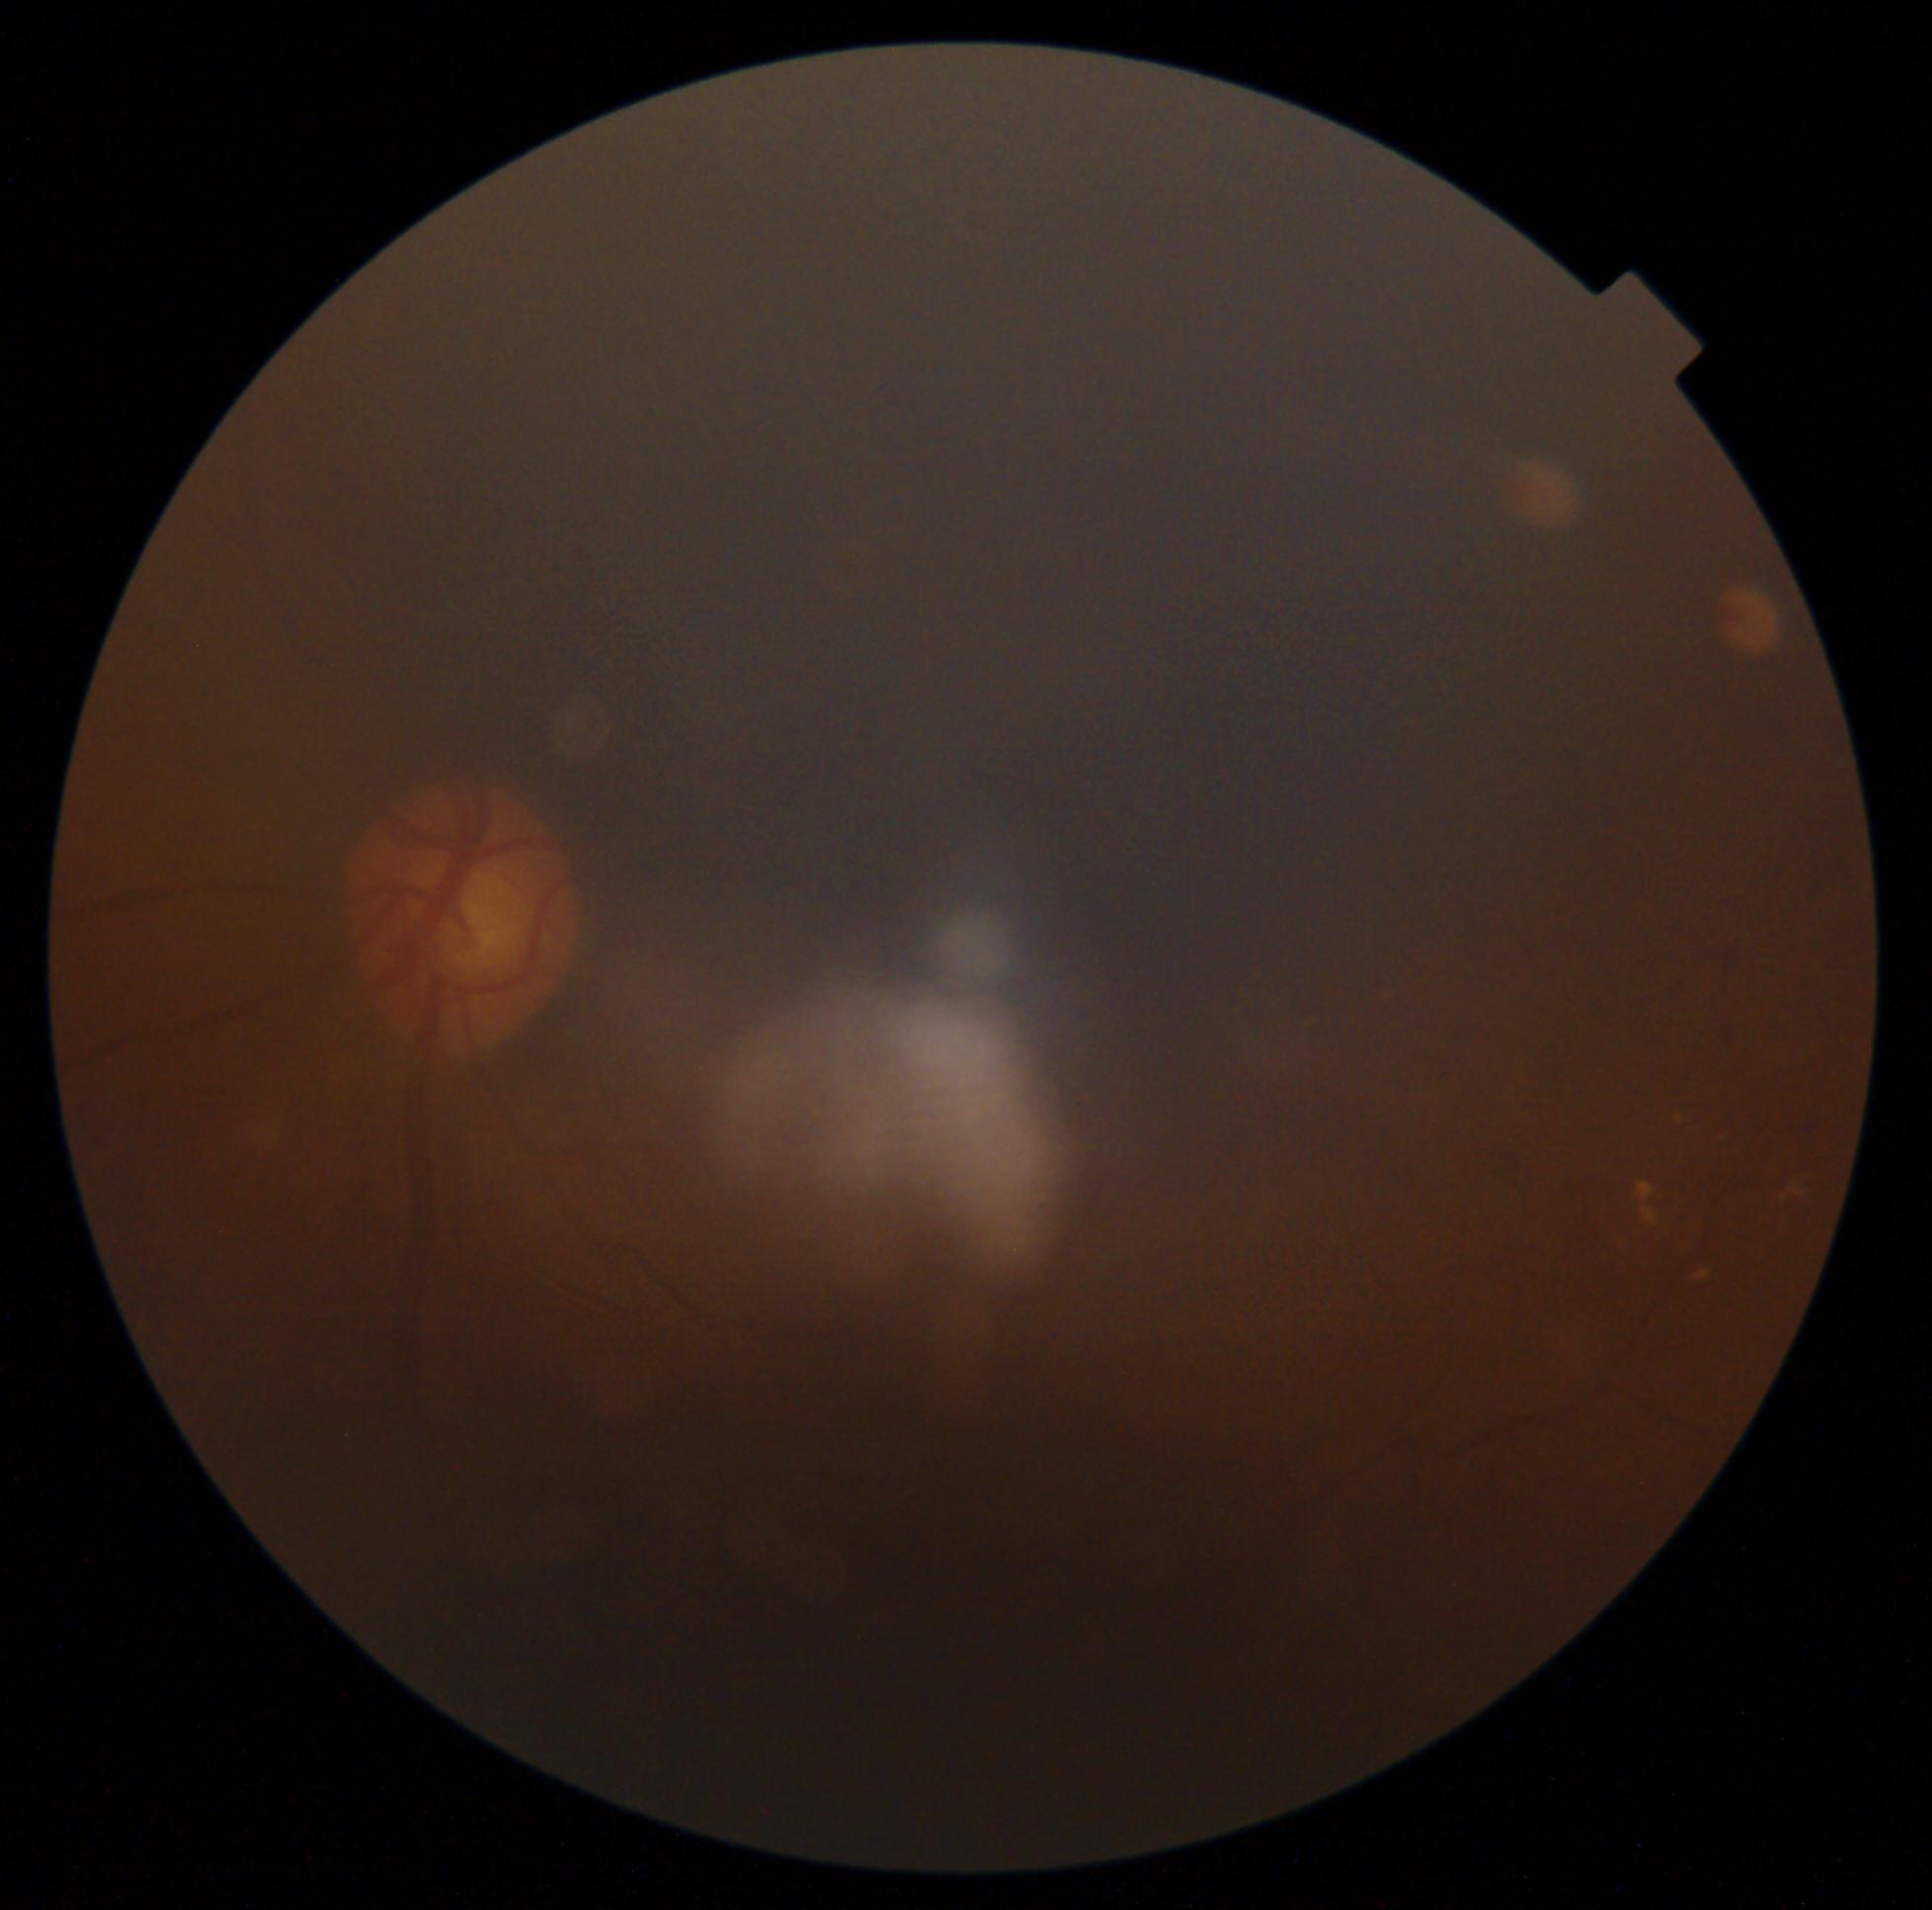 DR severity: 2/4 — more than just microaneurysms but less than severe NPDR.